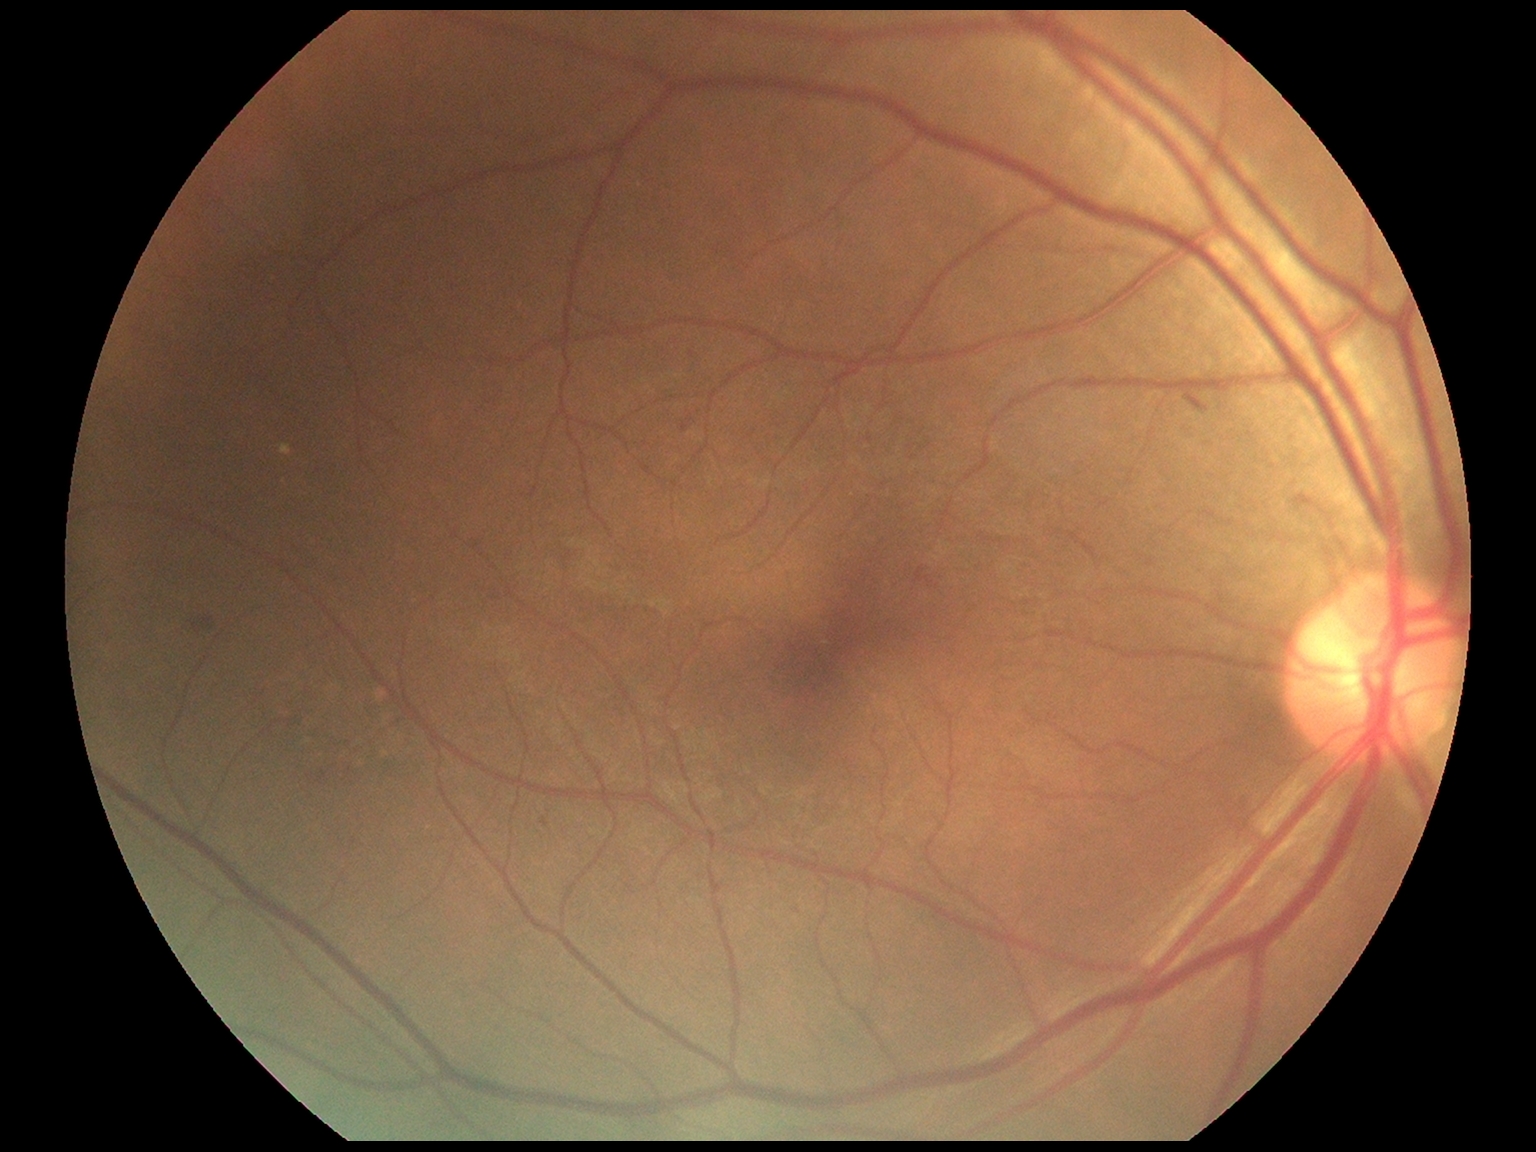

DR grade is 2 (moderate NPDR).